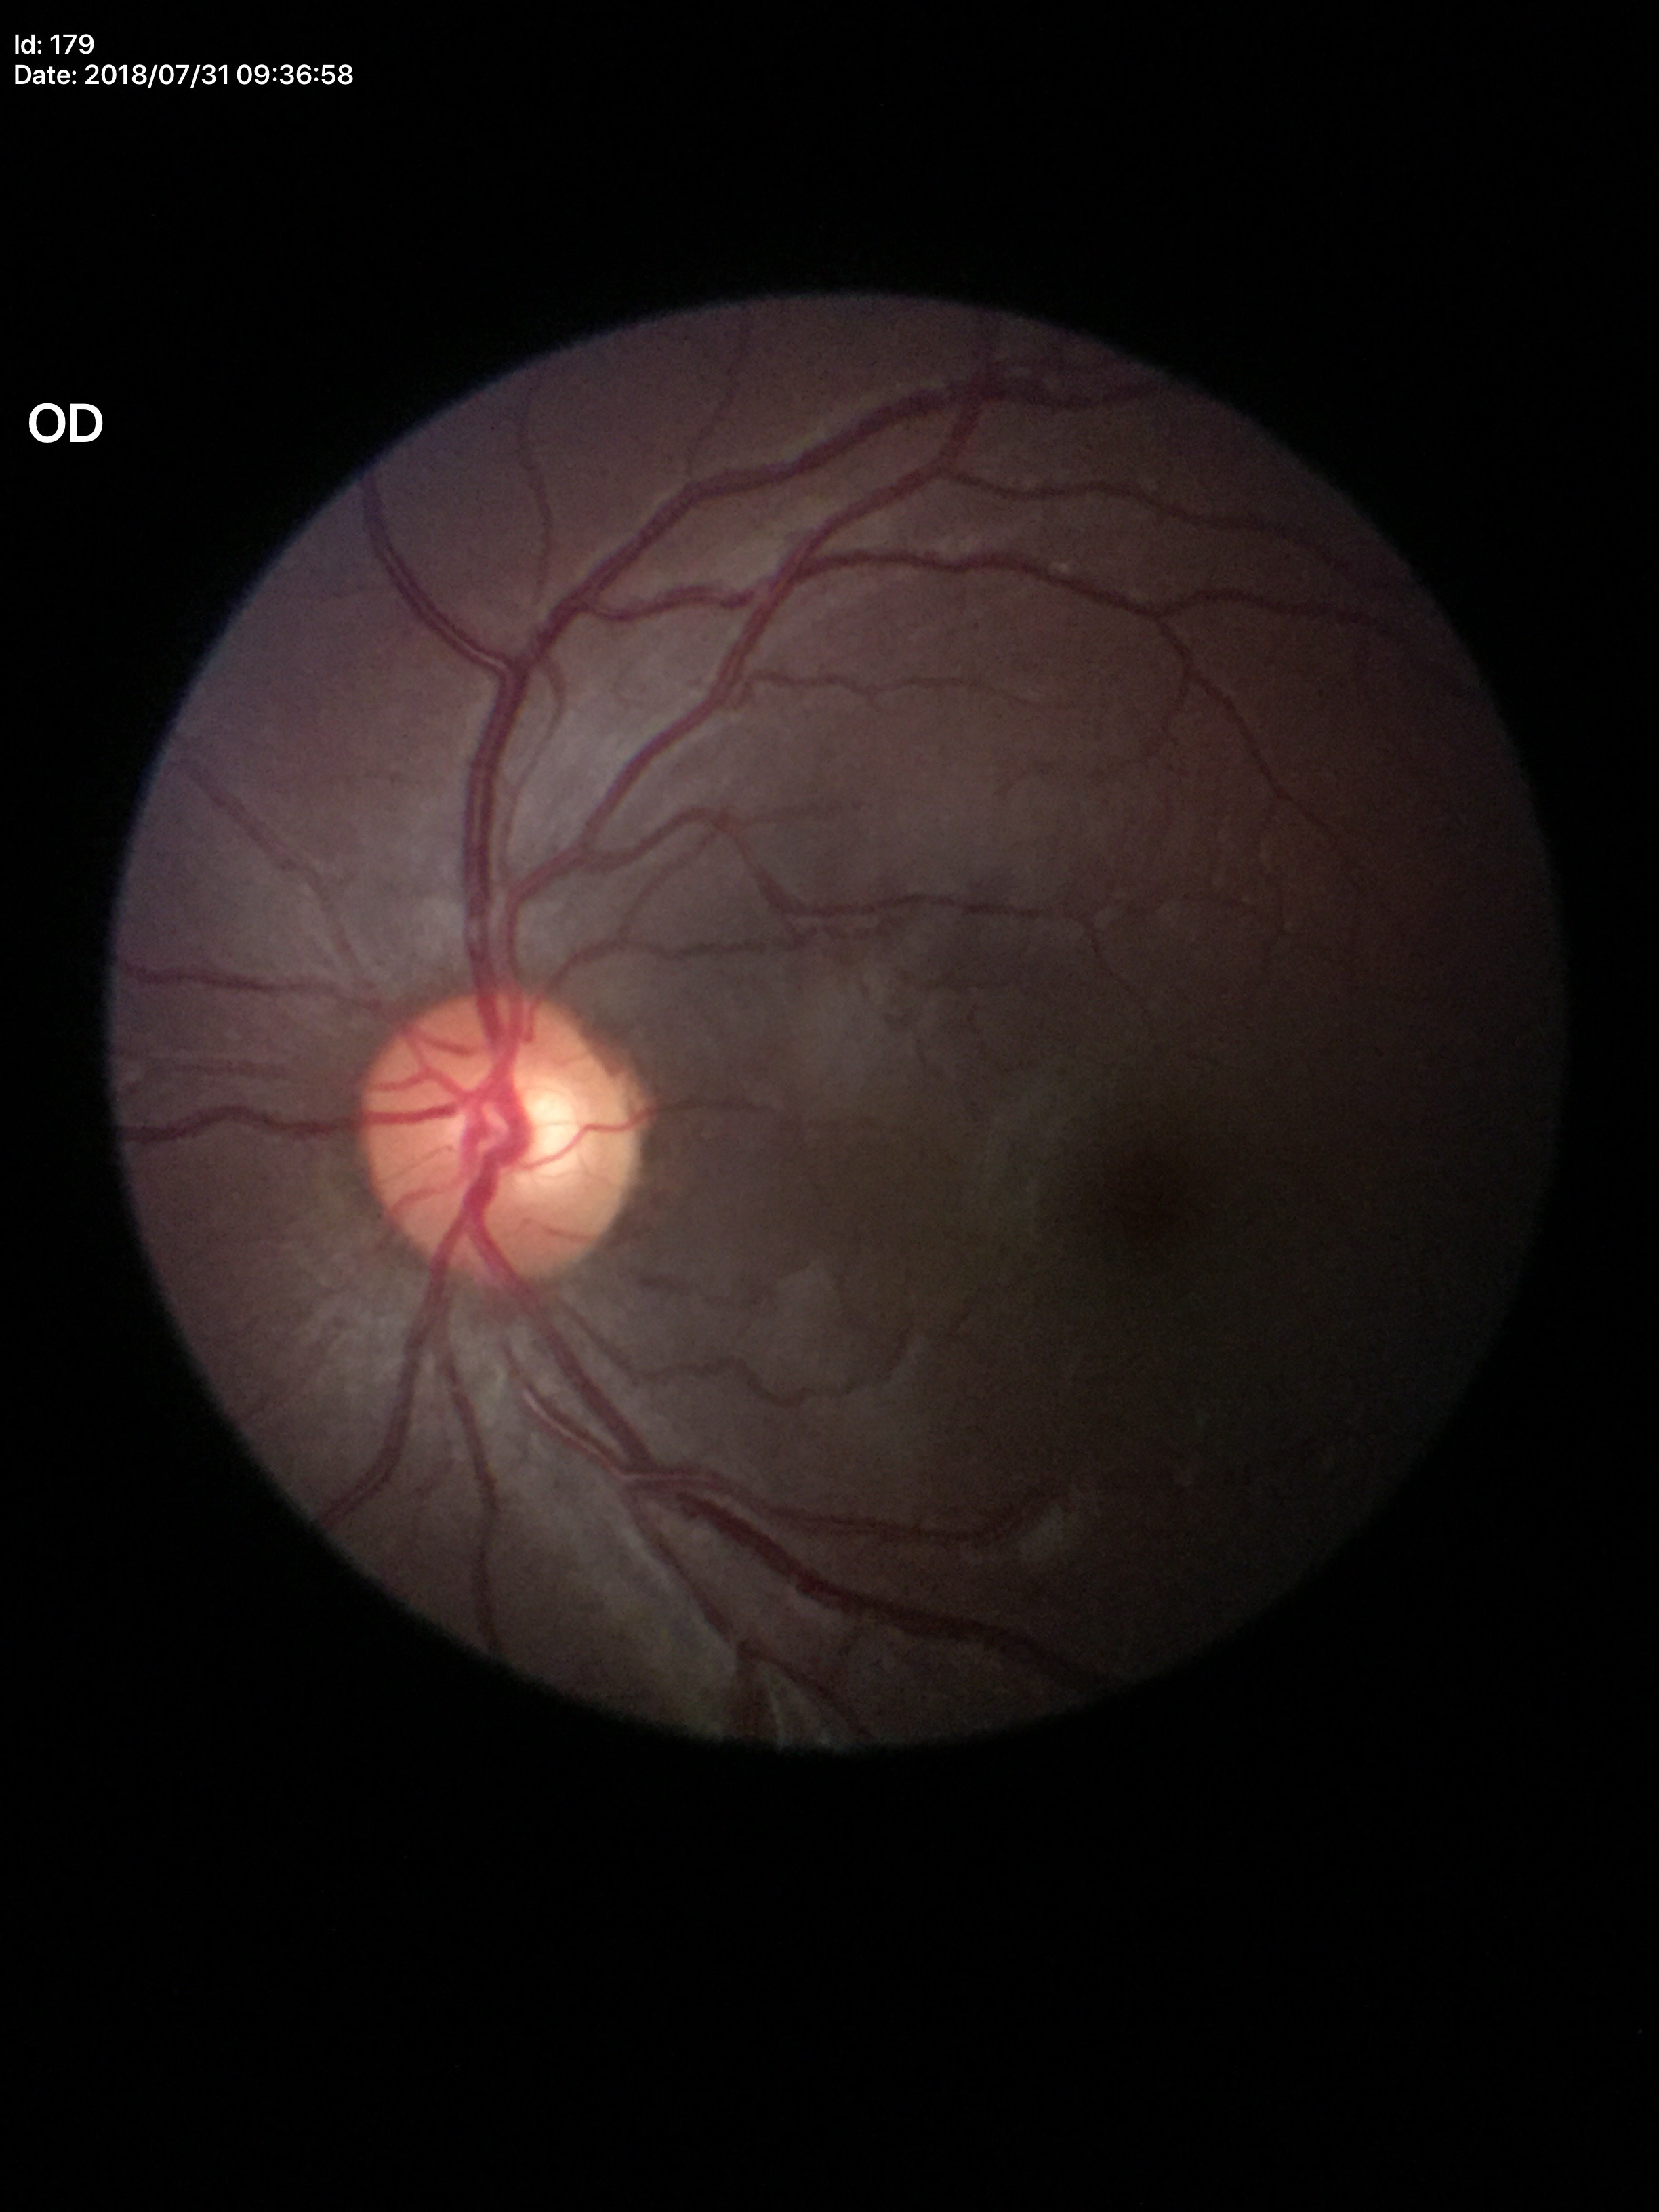 Glaucoma impression=negative (1/5 graders called glaucoma suspect); VCDR=0.56; ACDR=0.32; HCDR=0.58